Centered on the macula; captured on a Kowa VX-10α fundus camera; 50° field of view; color fundus image; mydriatic (tropicamide 0.5%)
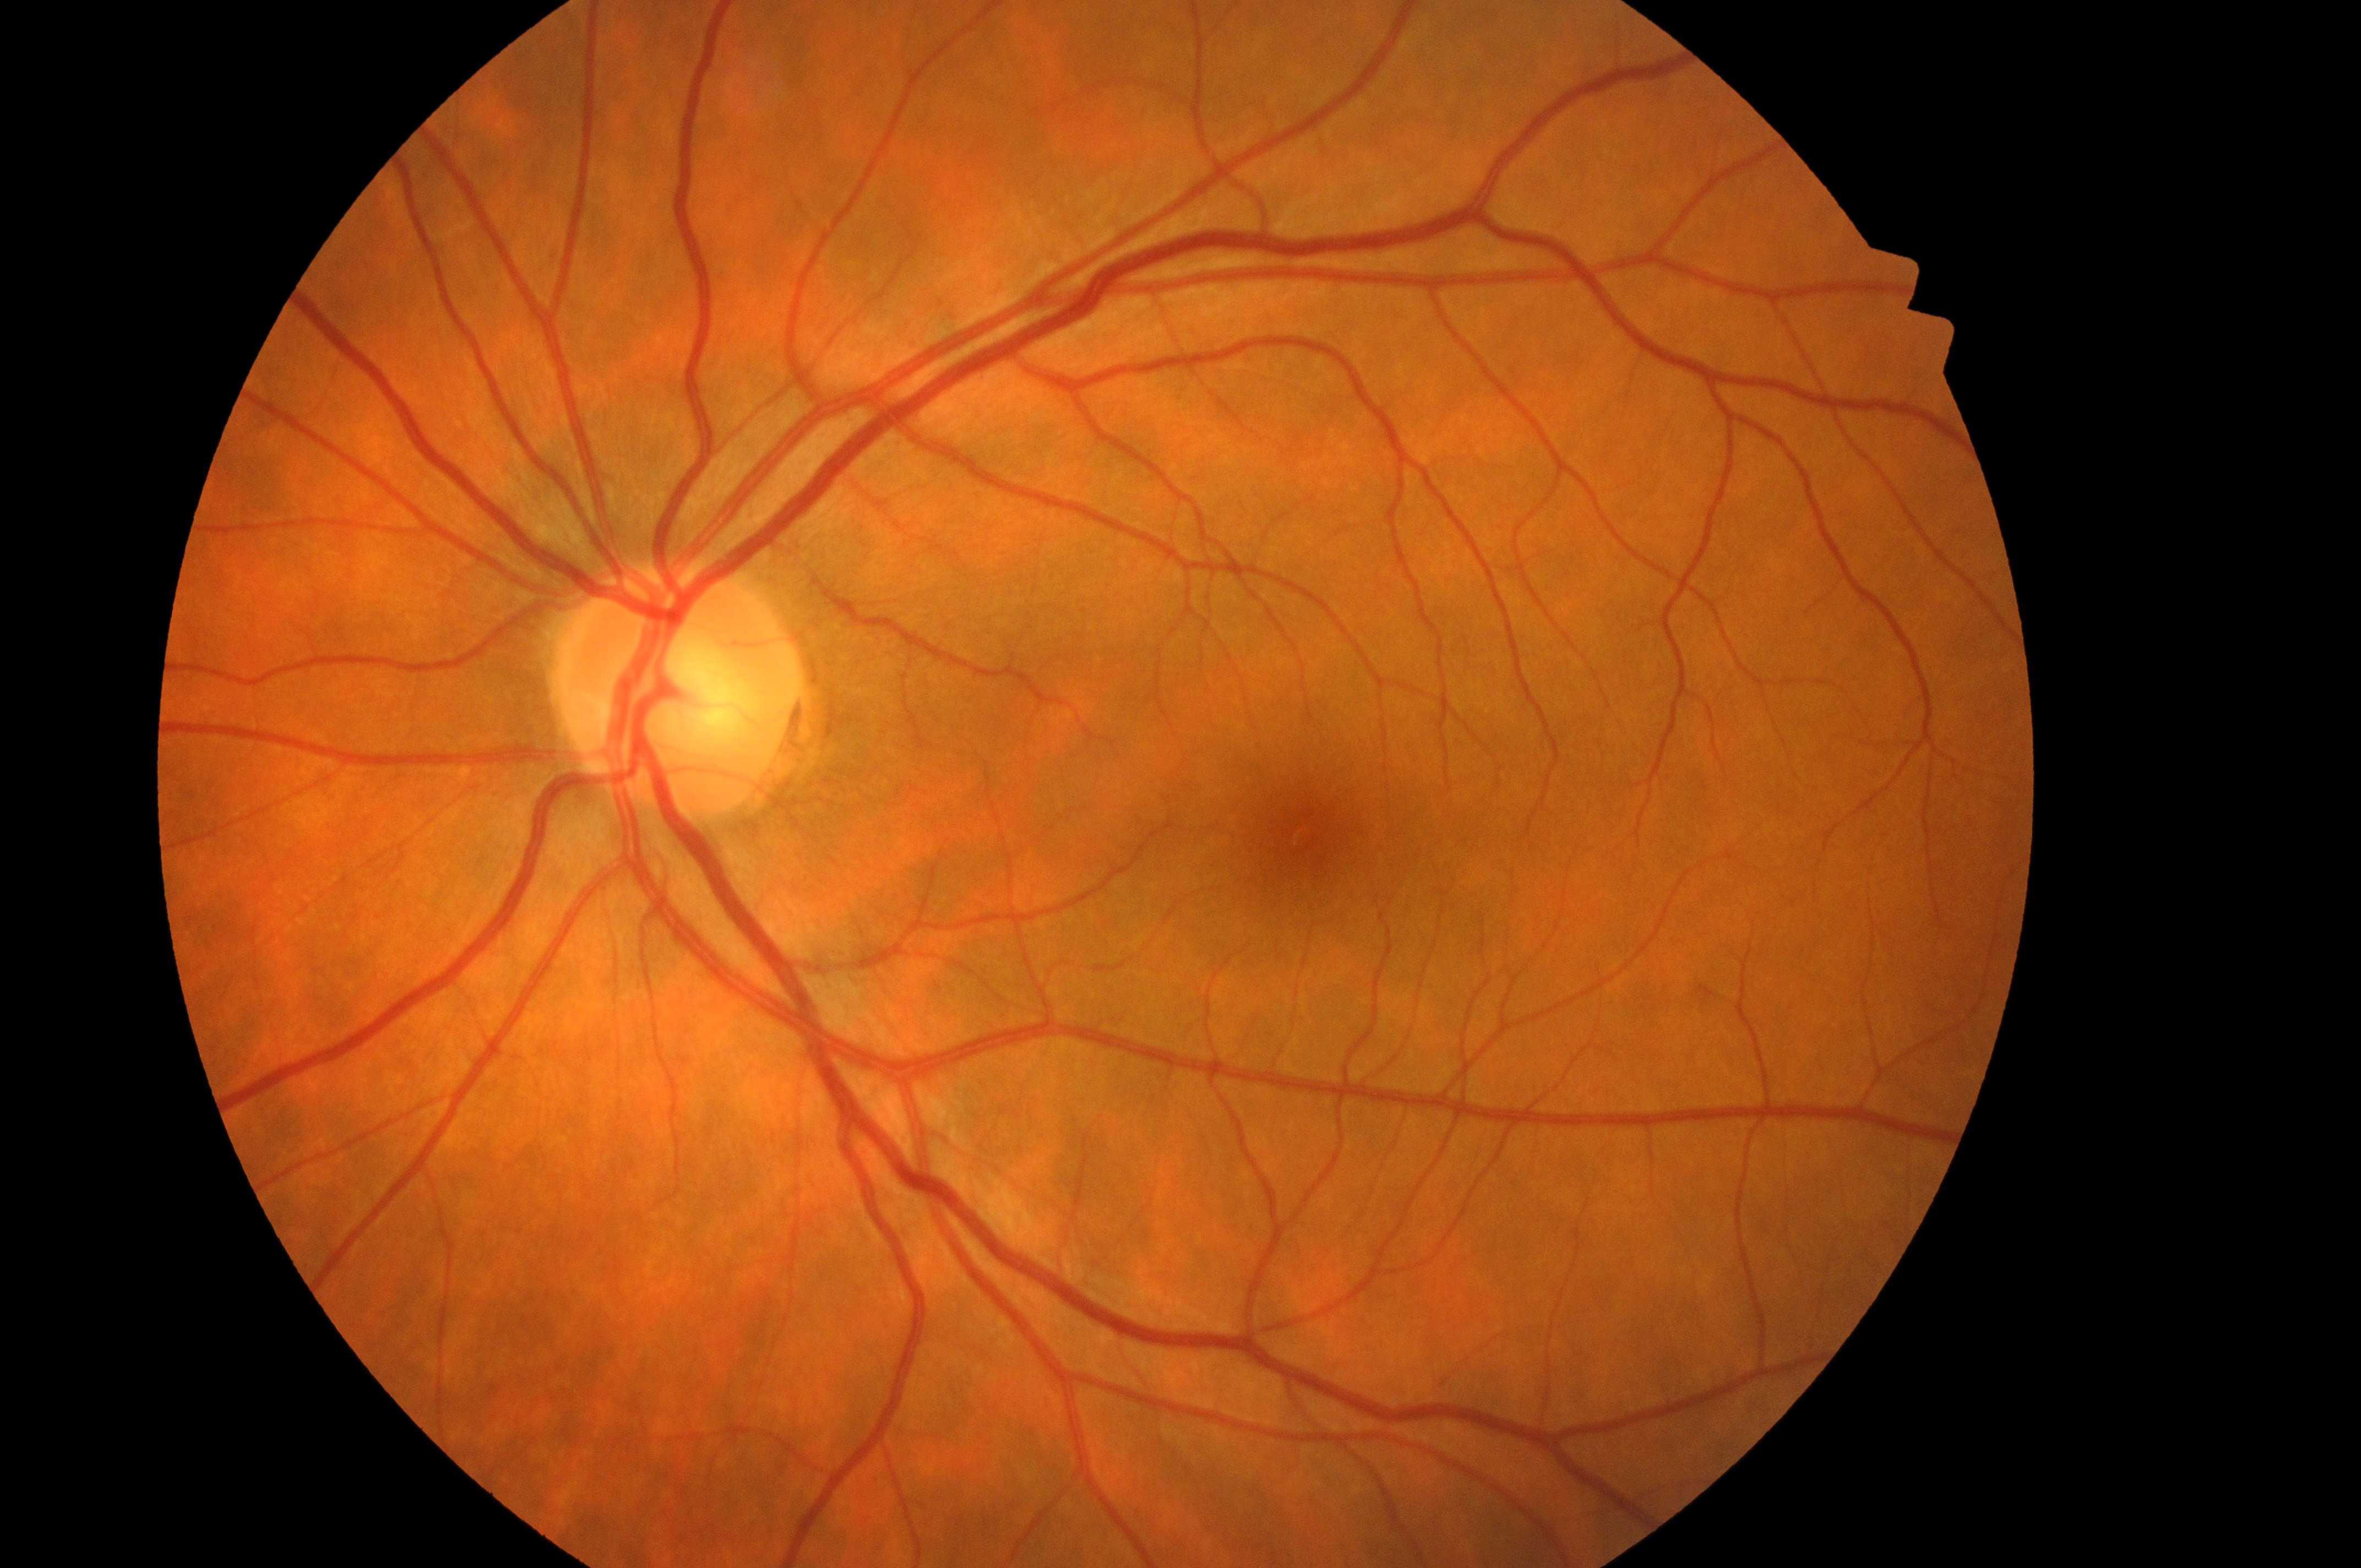 Macular edema risk: no risk (grade 0).
No diabetic retinopathy; no macular edema risk.
Optic disc center located at (x: 674, y: 696).
Diabetic retinopathy grade is 0 (no apparent retinopathy).
Fovea center located at (x: 1308, y: 829).
Eye: OS.